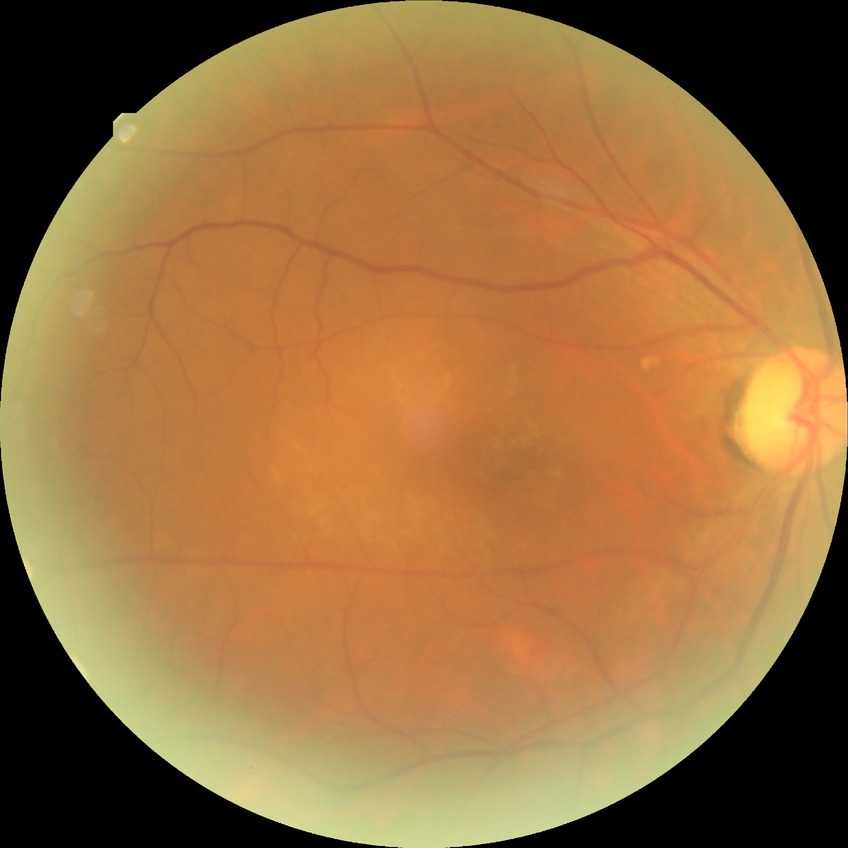
Diabetic retinopathy (DR) is NDR (no diabetic retinopathy).